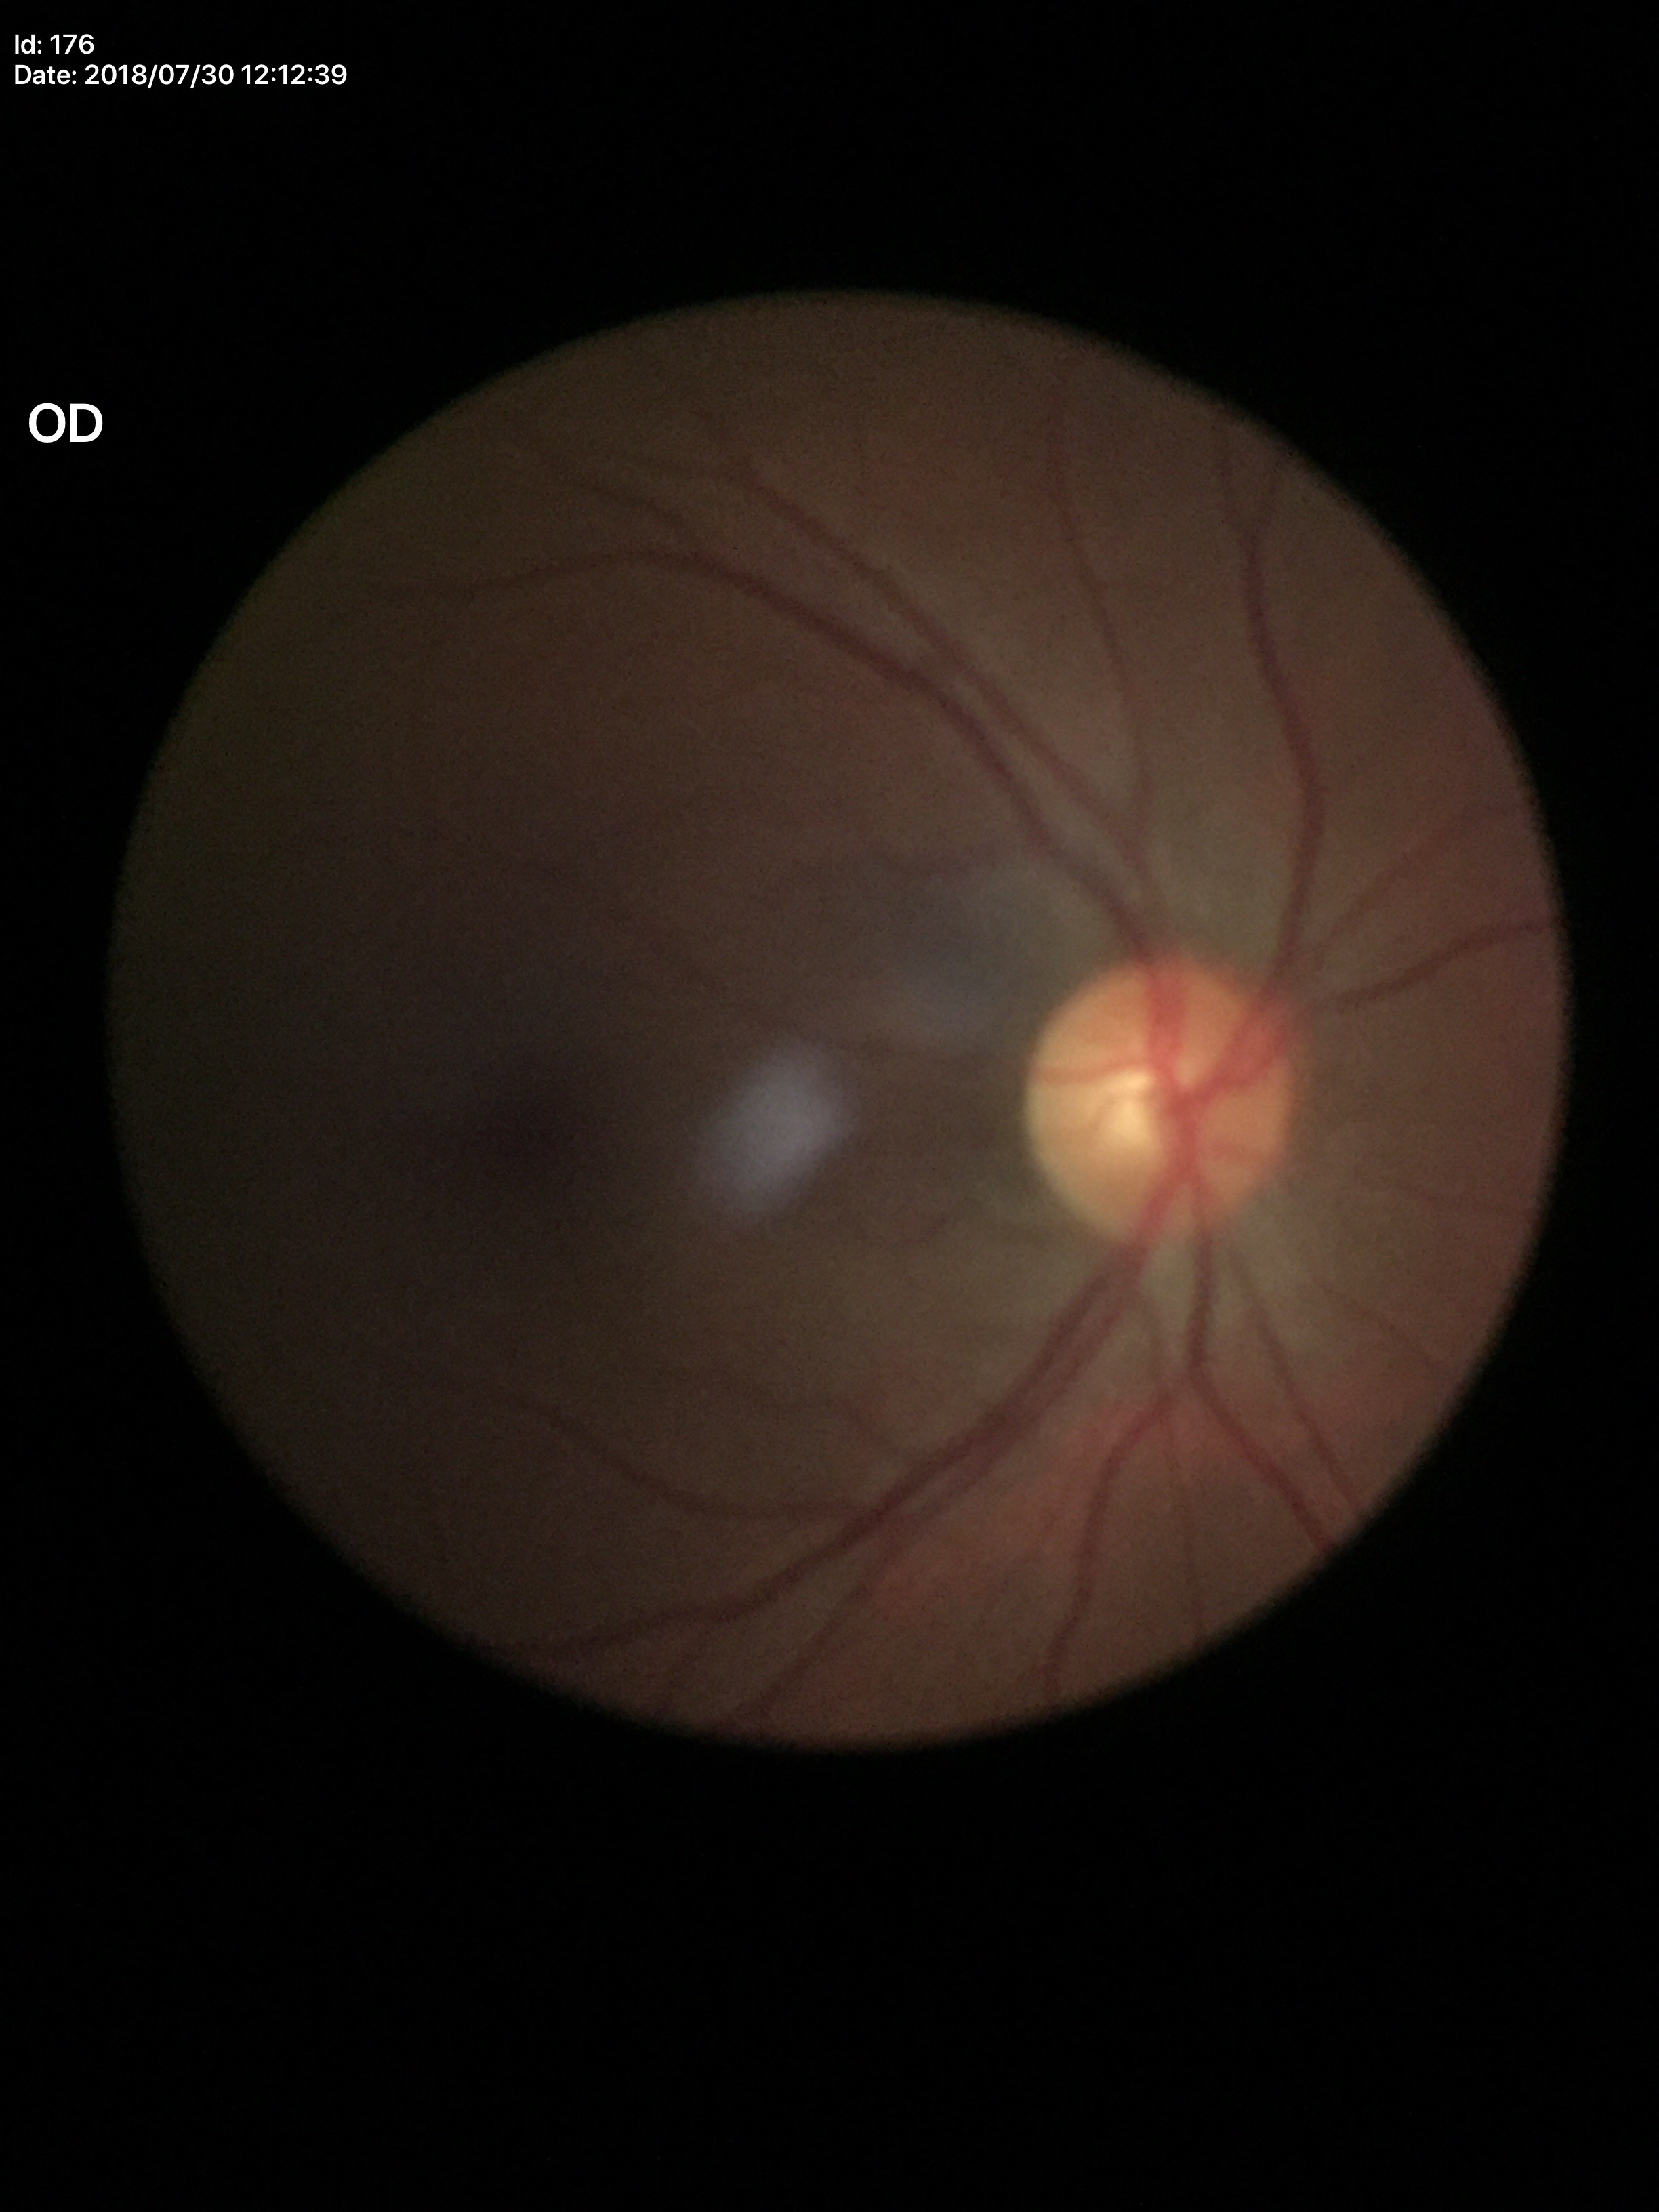
No glaucomatous optic neuropathy.
Vertical cup-disc ratio is 0.47.